Wide-field retinal mosaic image:
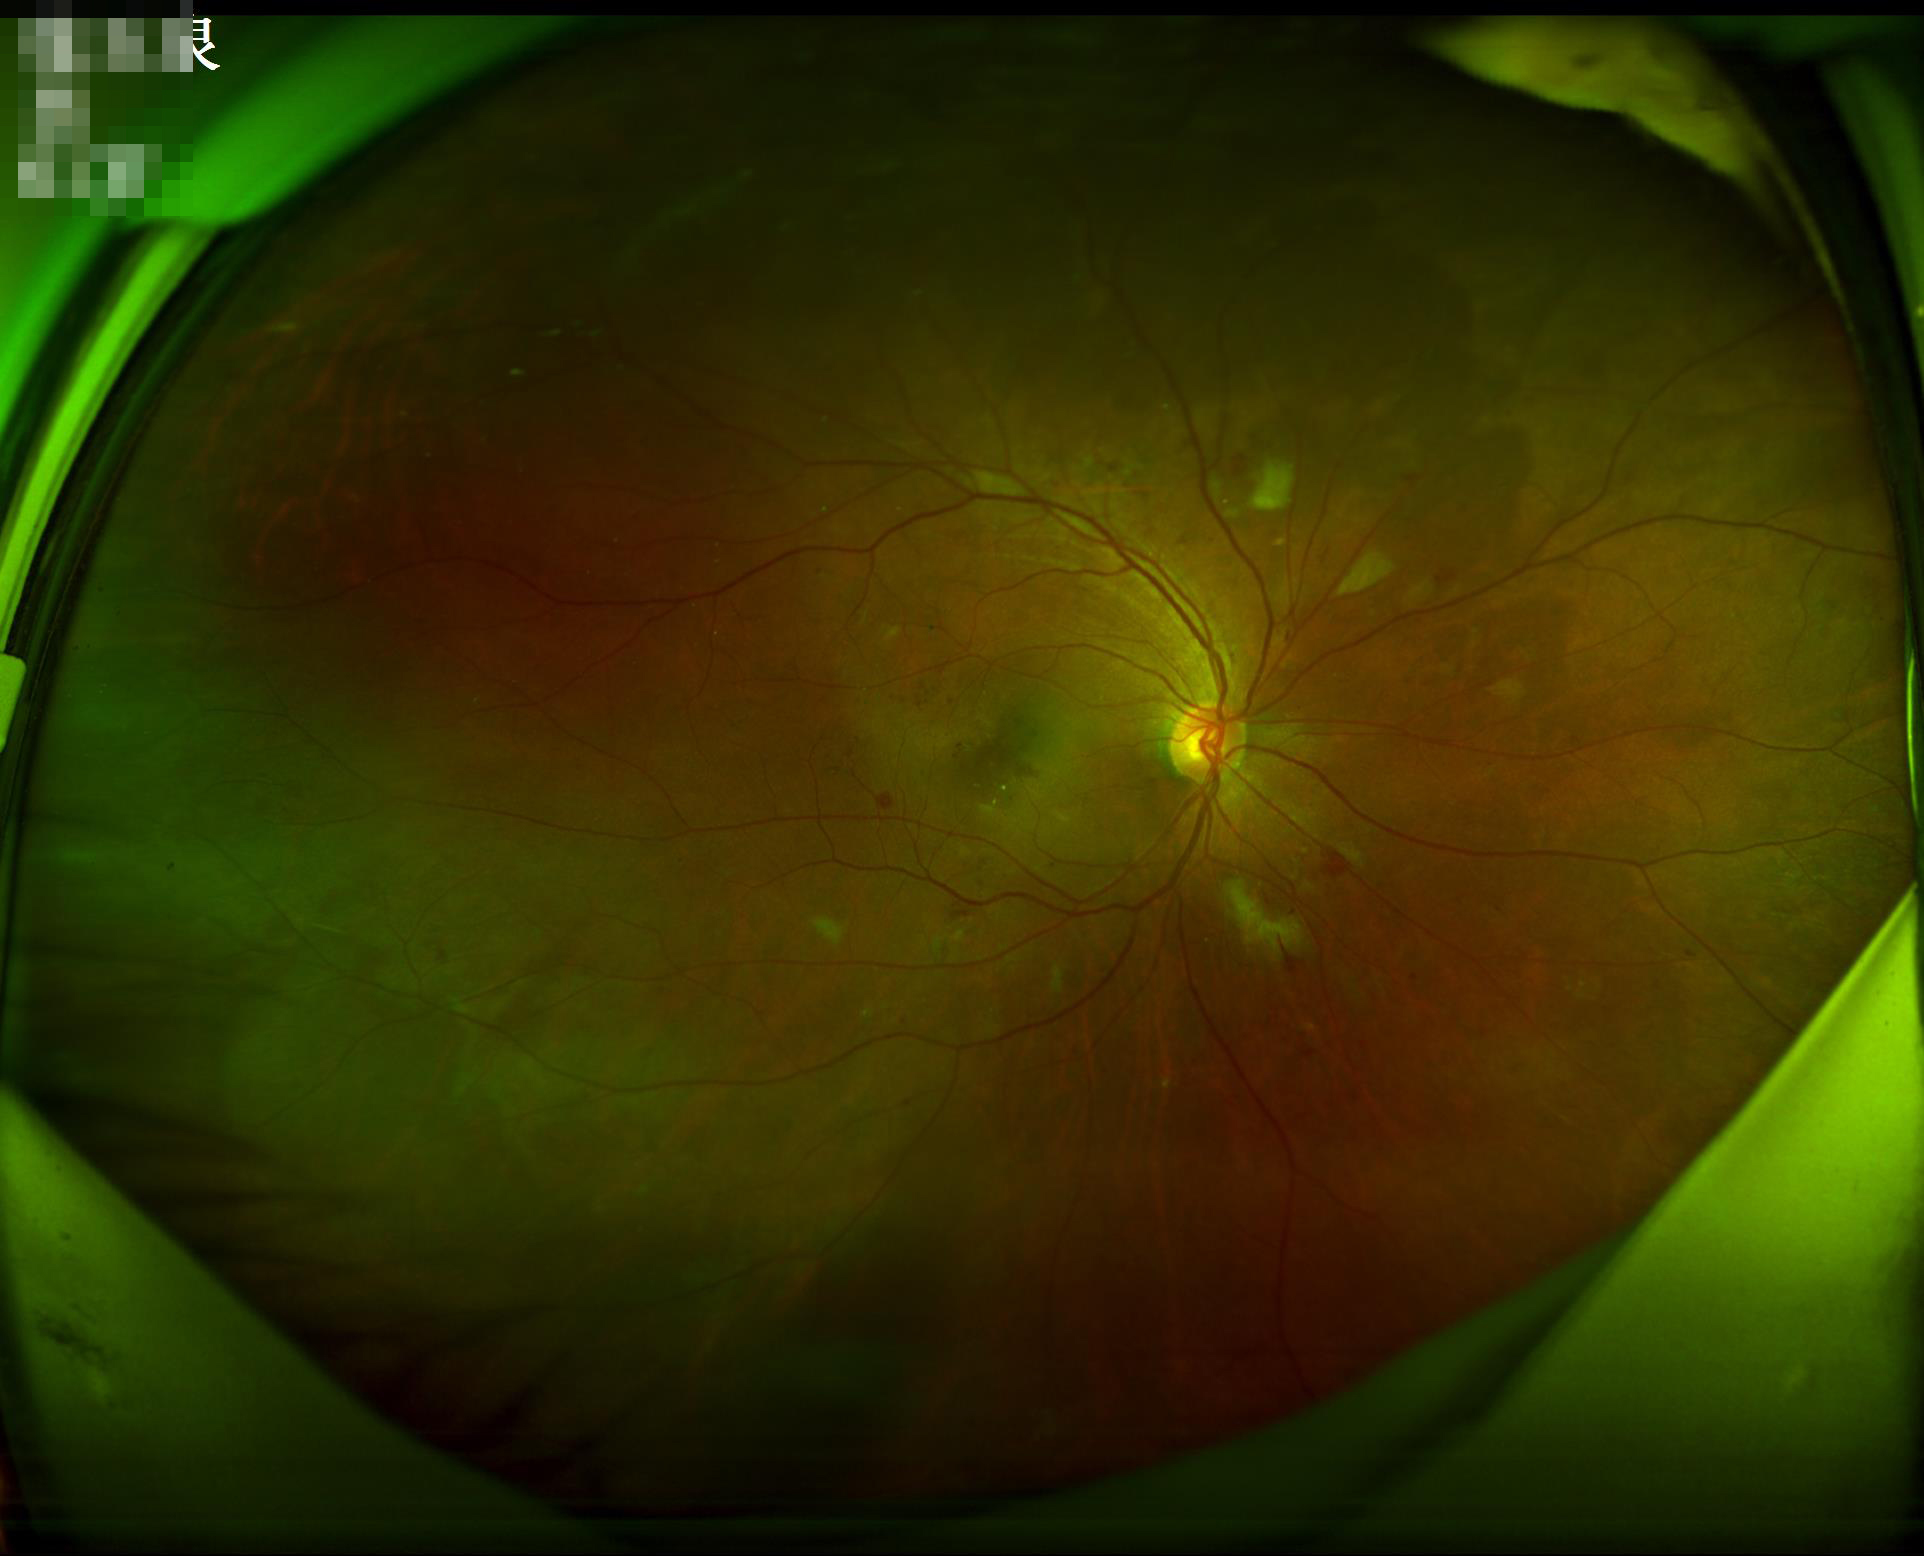 clarity: good
overall_quality: good
contrast: good
illumination: adequate